Image size 240x240:
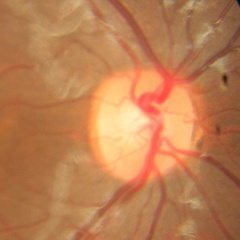

Findings consistent with no evidence of glaucoma.